No pharmacologic dilation. Modified Davis classification. Retinal fundus photograph. 848x848px. 45 degree fundus photograph:
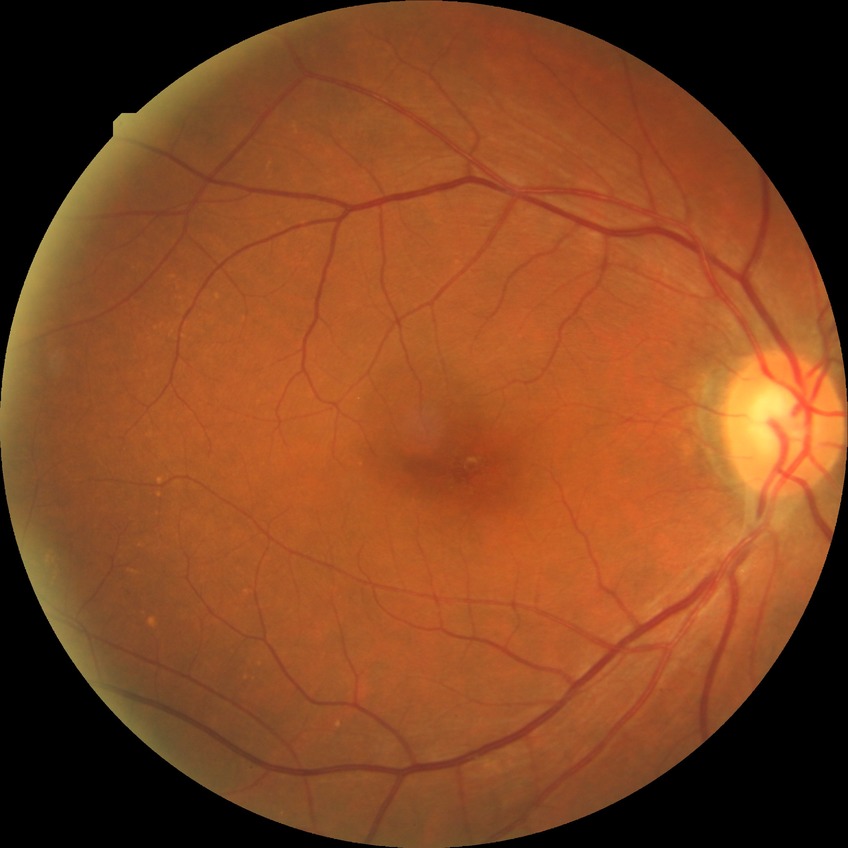

Davis grade is NDR.